Wide-field fundus photograph from neonatal ROP screening: 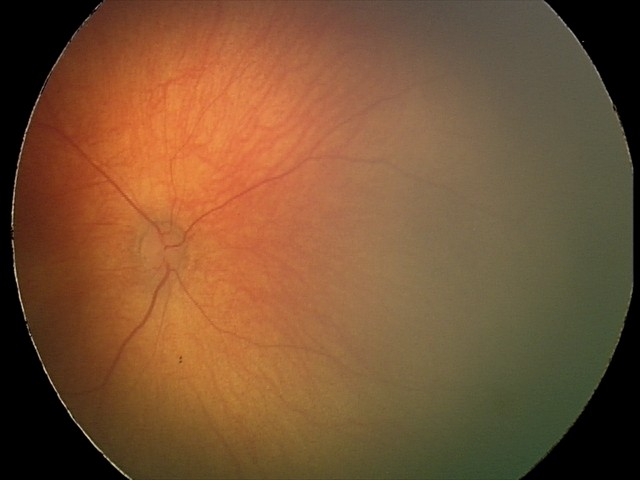
Assessment = no abnormalities